Wide-field fundus photograph from neonatal ROP screening.
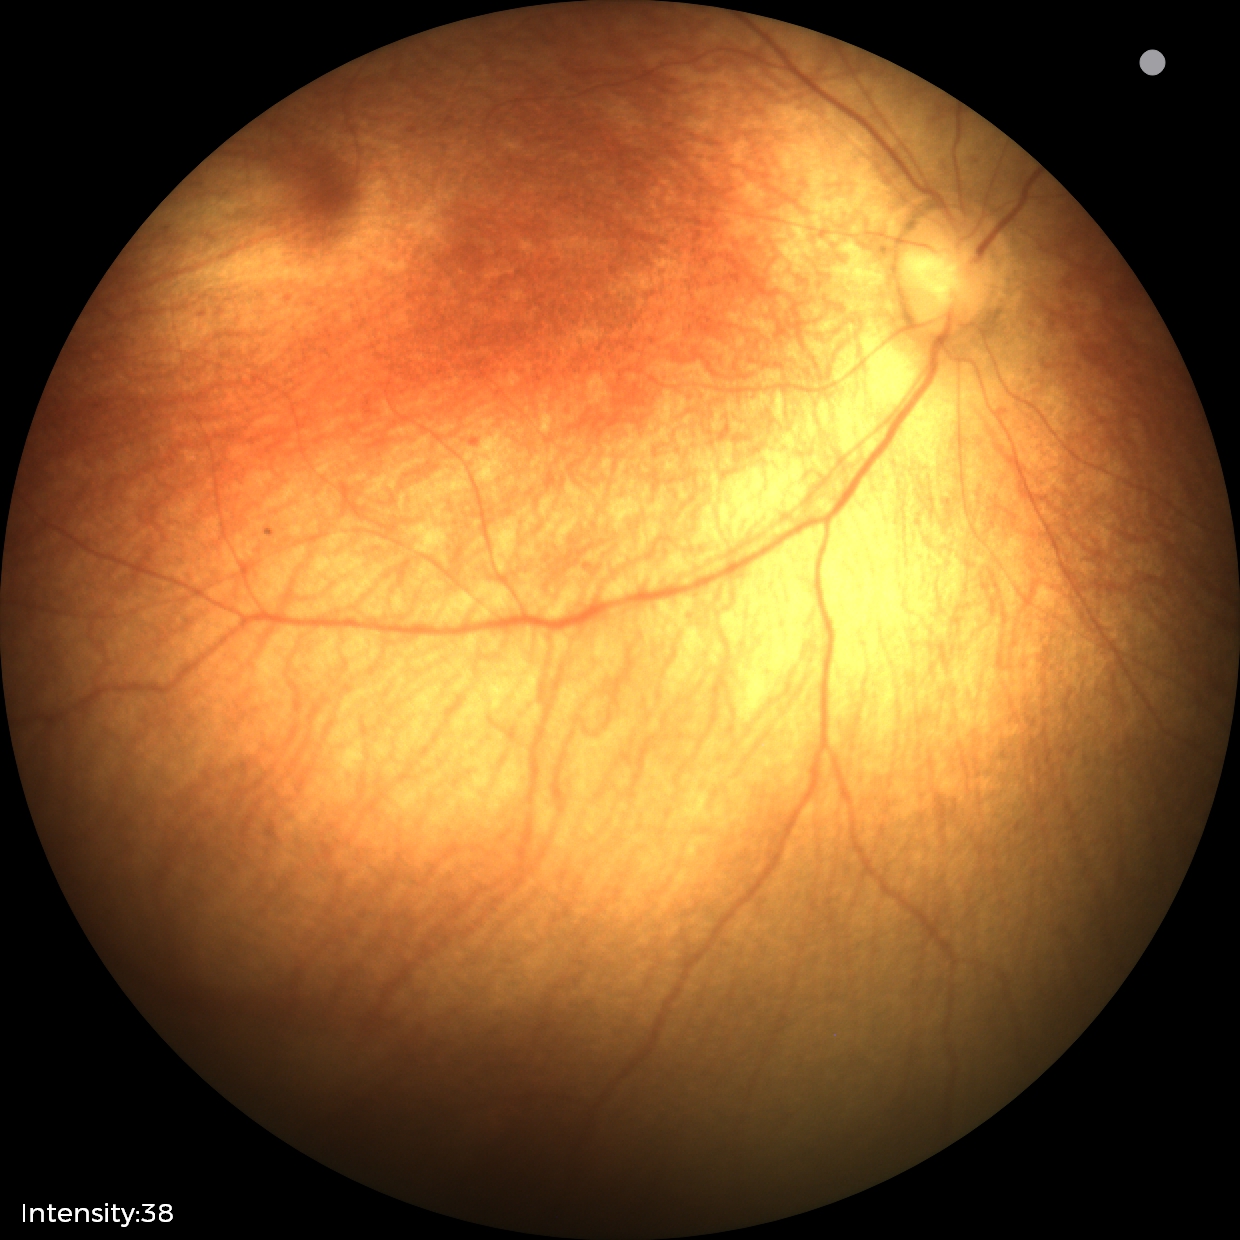
Q: What was the screening finding?
A: physiological appearance with no retinal pathology